1240x1240px · Phoenix ICON wide-field infant fundus image: 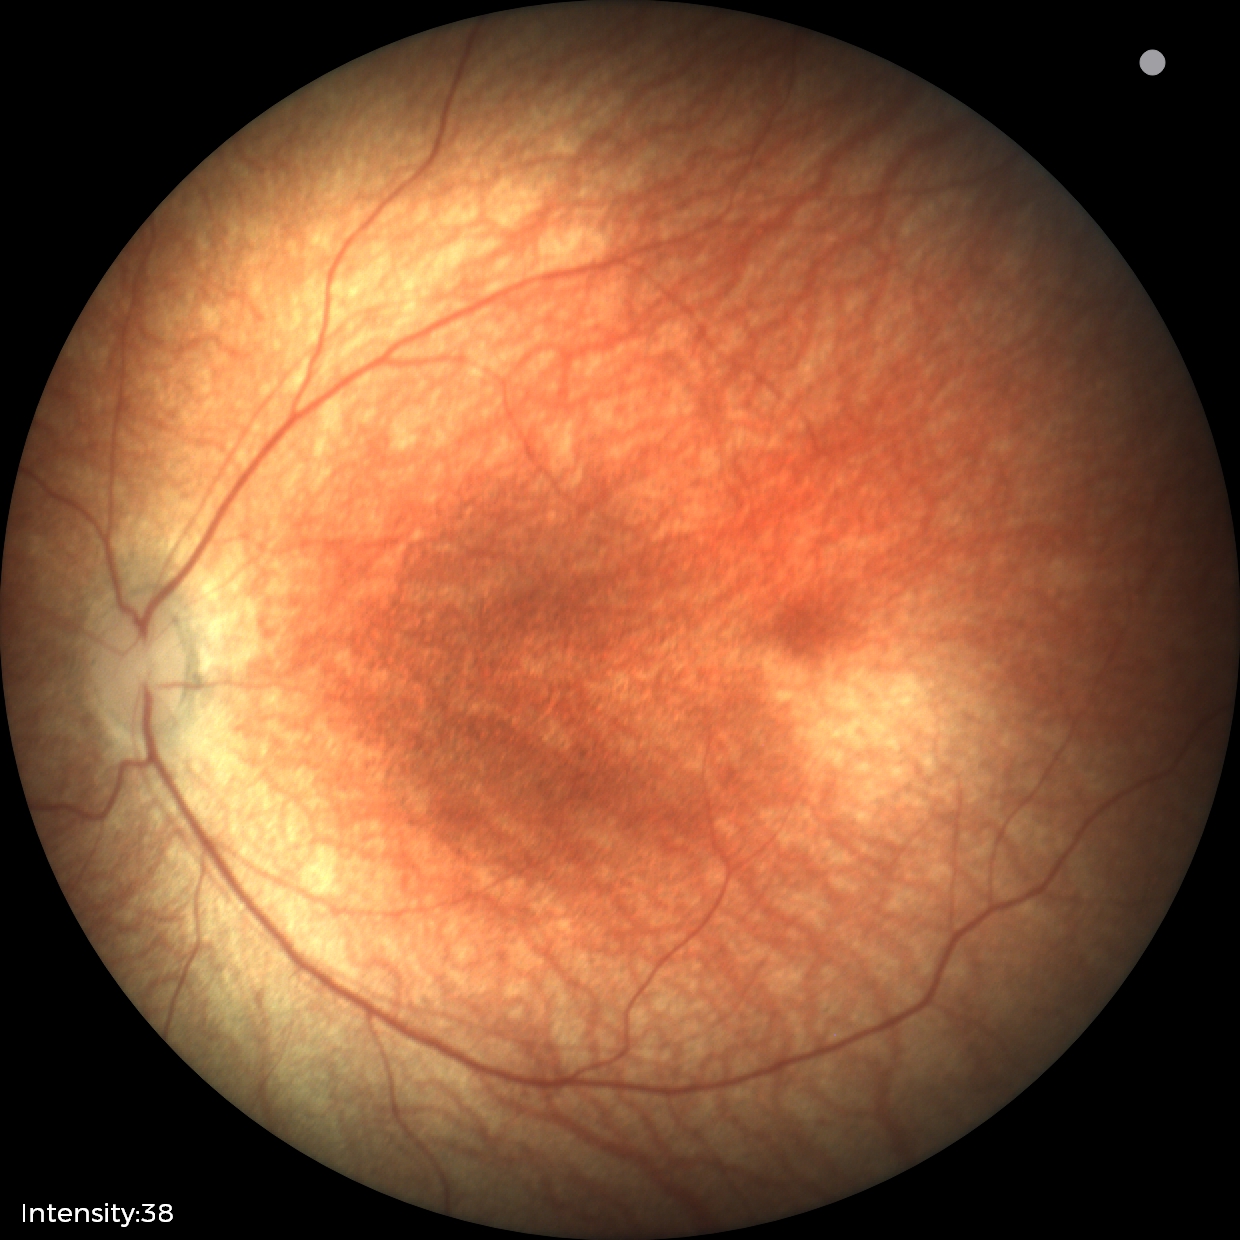

Diagnosis: physiological.